Pediatric wide-field fundus photograph.
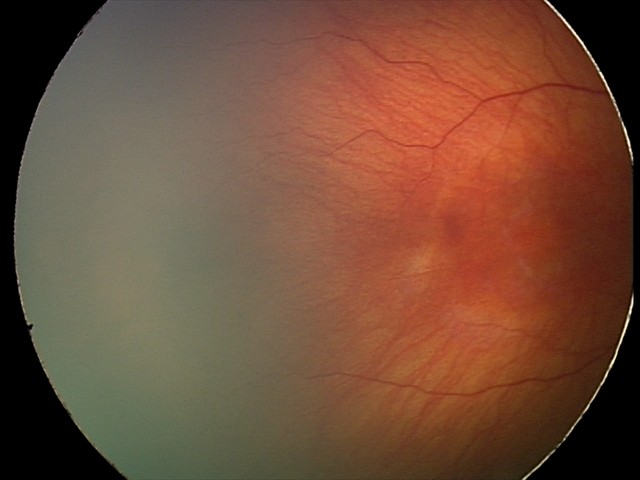 Screening series with status post ROP. Without plus disease.